Retinal fundus photograph, acquired with a NIDEK AFC-230, 848 by 848 pixels:
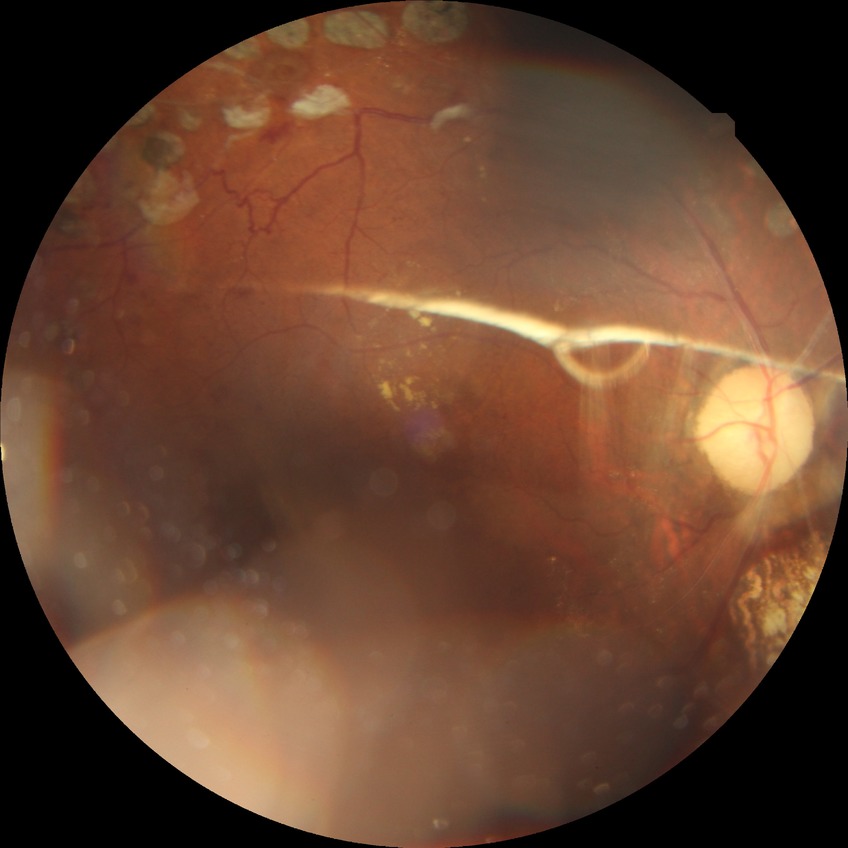

Diabetic retinopathy (DR): proliferative diabetic retinopathy (PDR).